Posterior pole photograph. FOV: 45 degrees. NIDEK AFC-230 fundus camera. Without pupil dilation
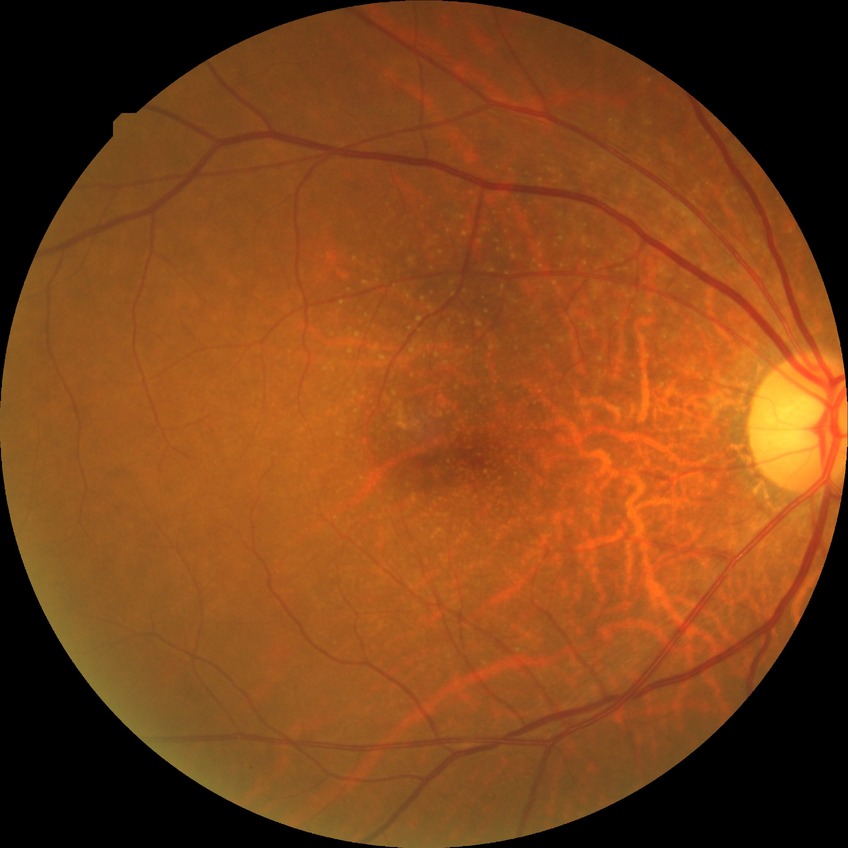

  davis_grade: no diabetic retinopathy